Graded on the modified Davis scale, 848 x 848 pixels, fundus photo: 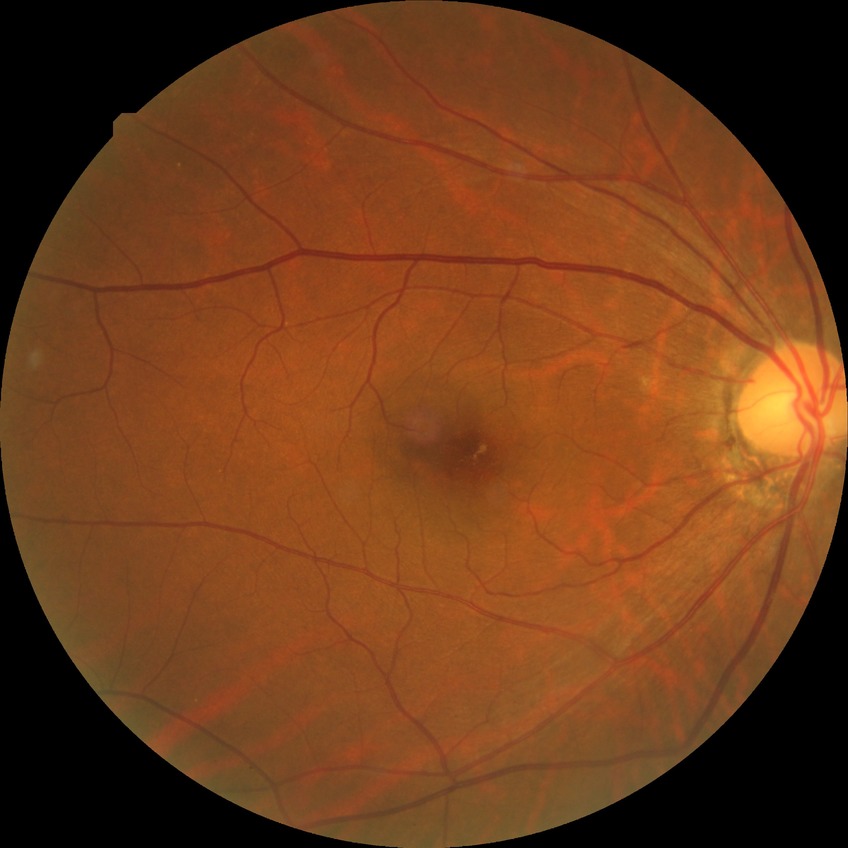 {
  "davis_grade": "no diabetic retinopathy (NDR)"
}